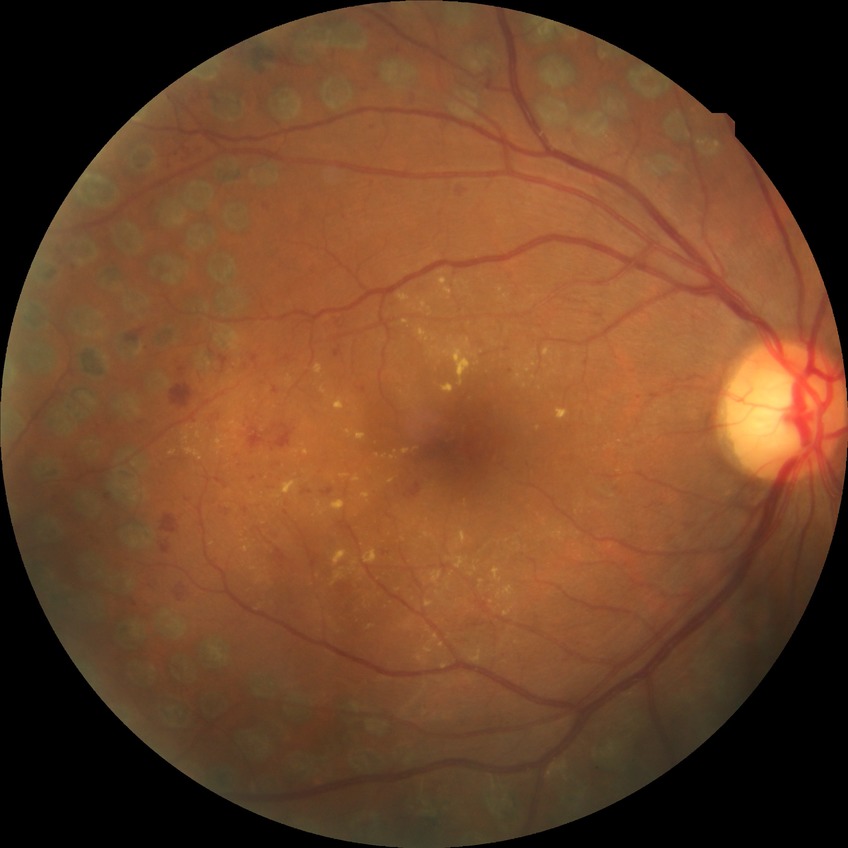

Diabetic retinopathy stage is proliferative diabetic retinopathy.